Modified Davis grading; 45° FOV.
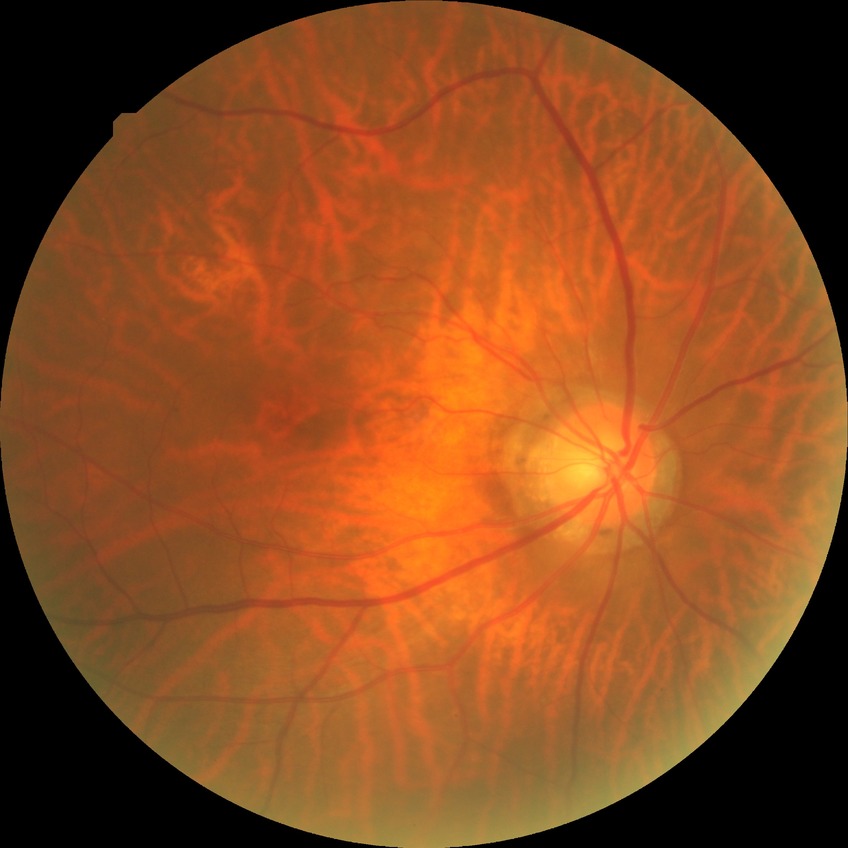

diabetic retinopathy grade: no diabetic retinopathy.